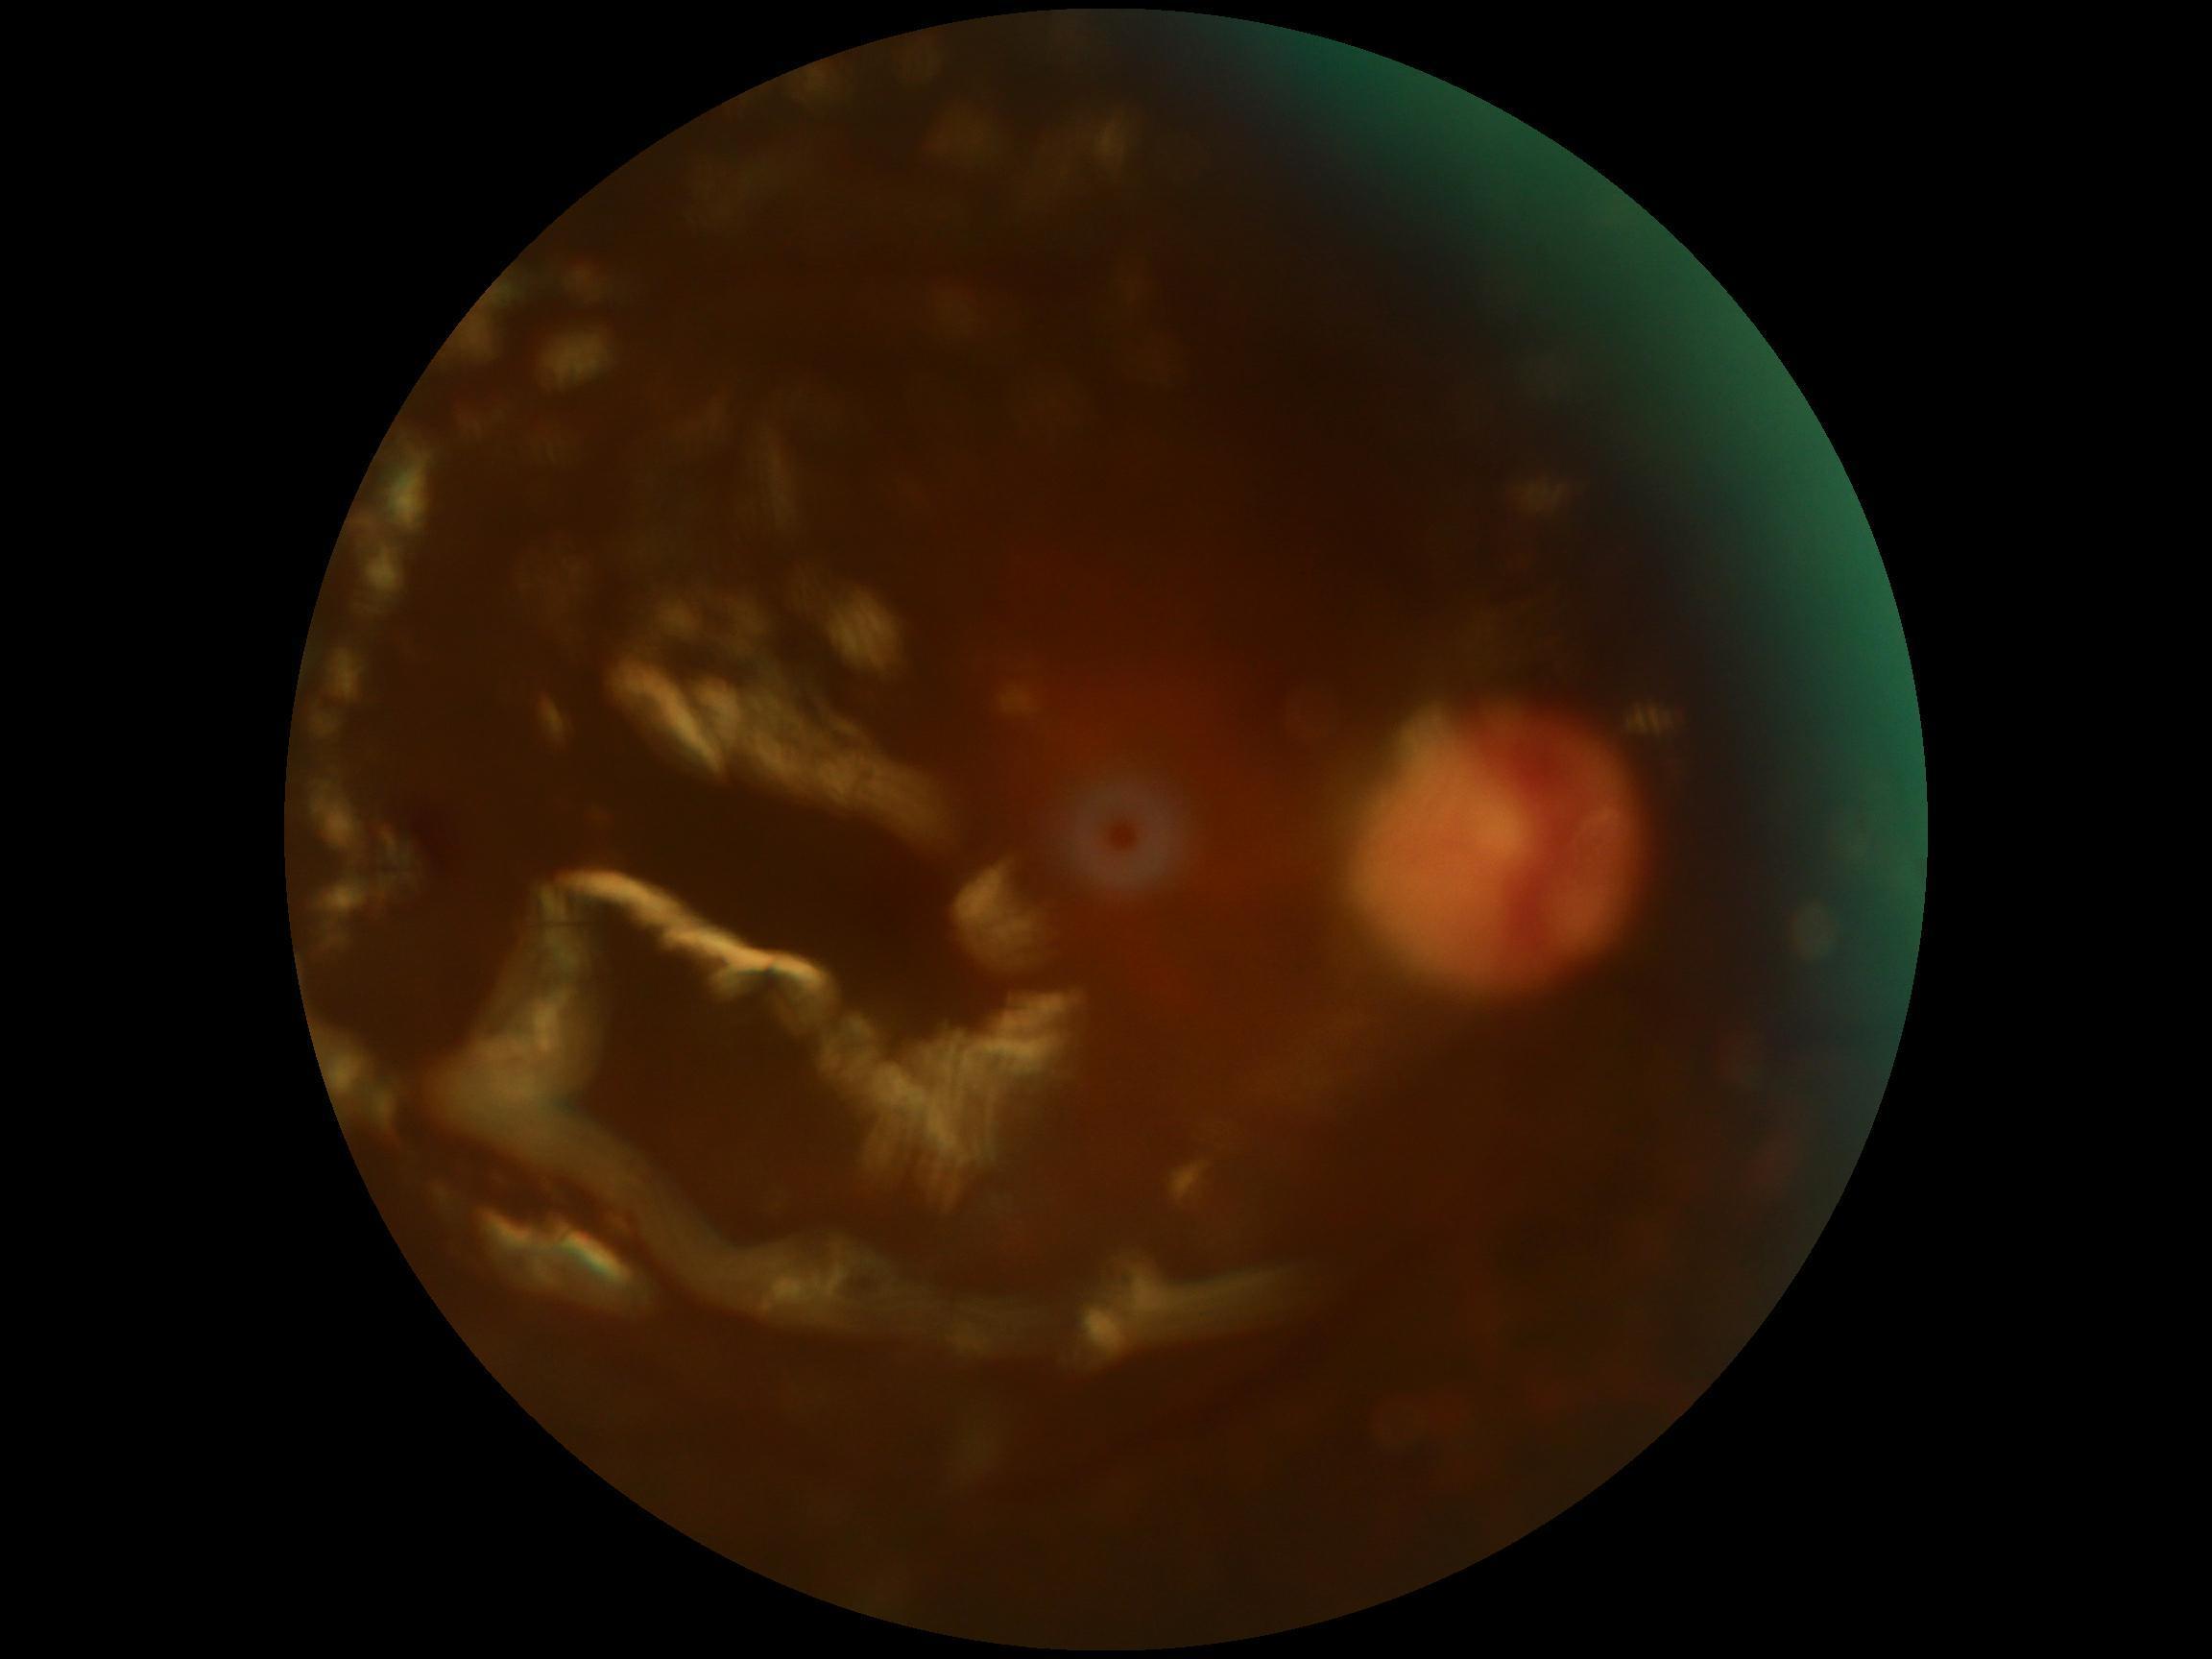
Findings:
- image quality — too poor for DR grading
- diabetic retinopathy (DR) — ungradable due to poor image quality